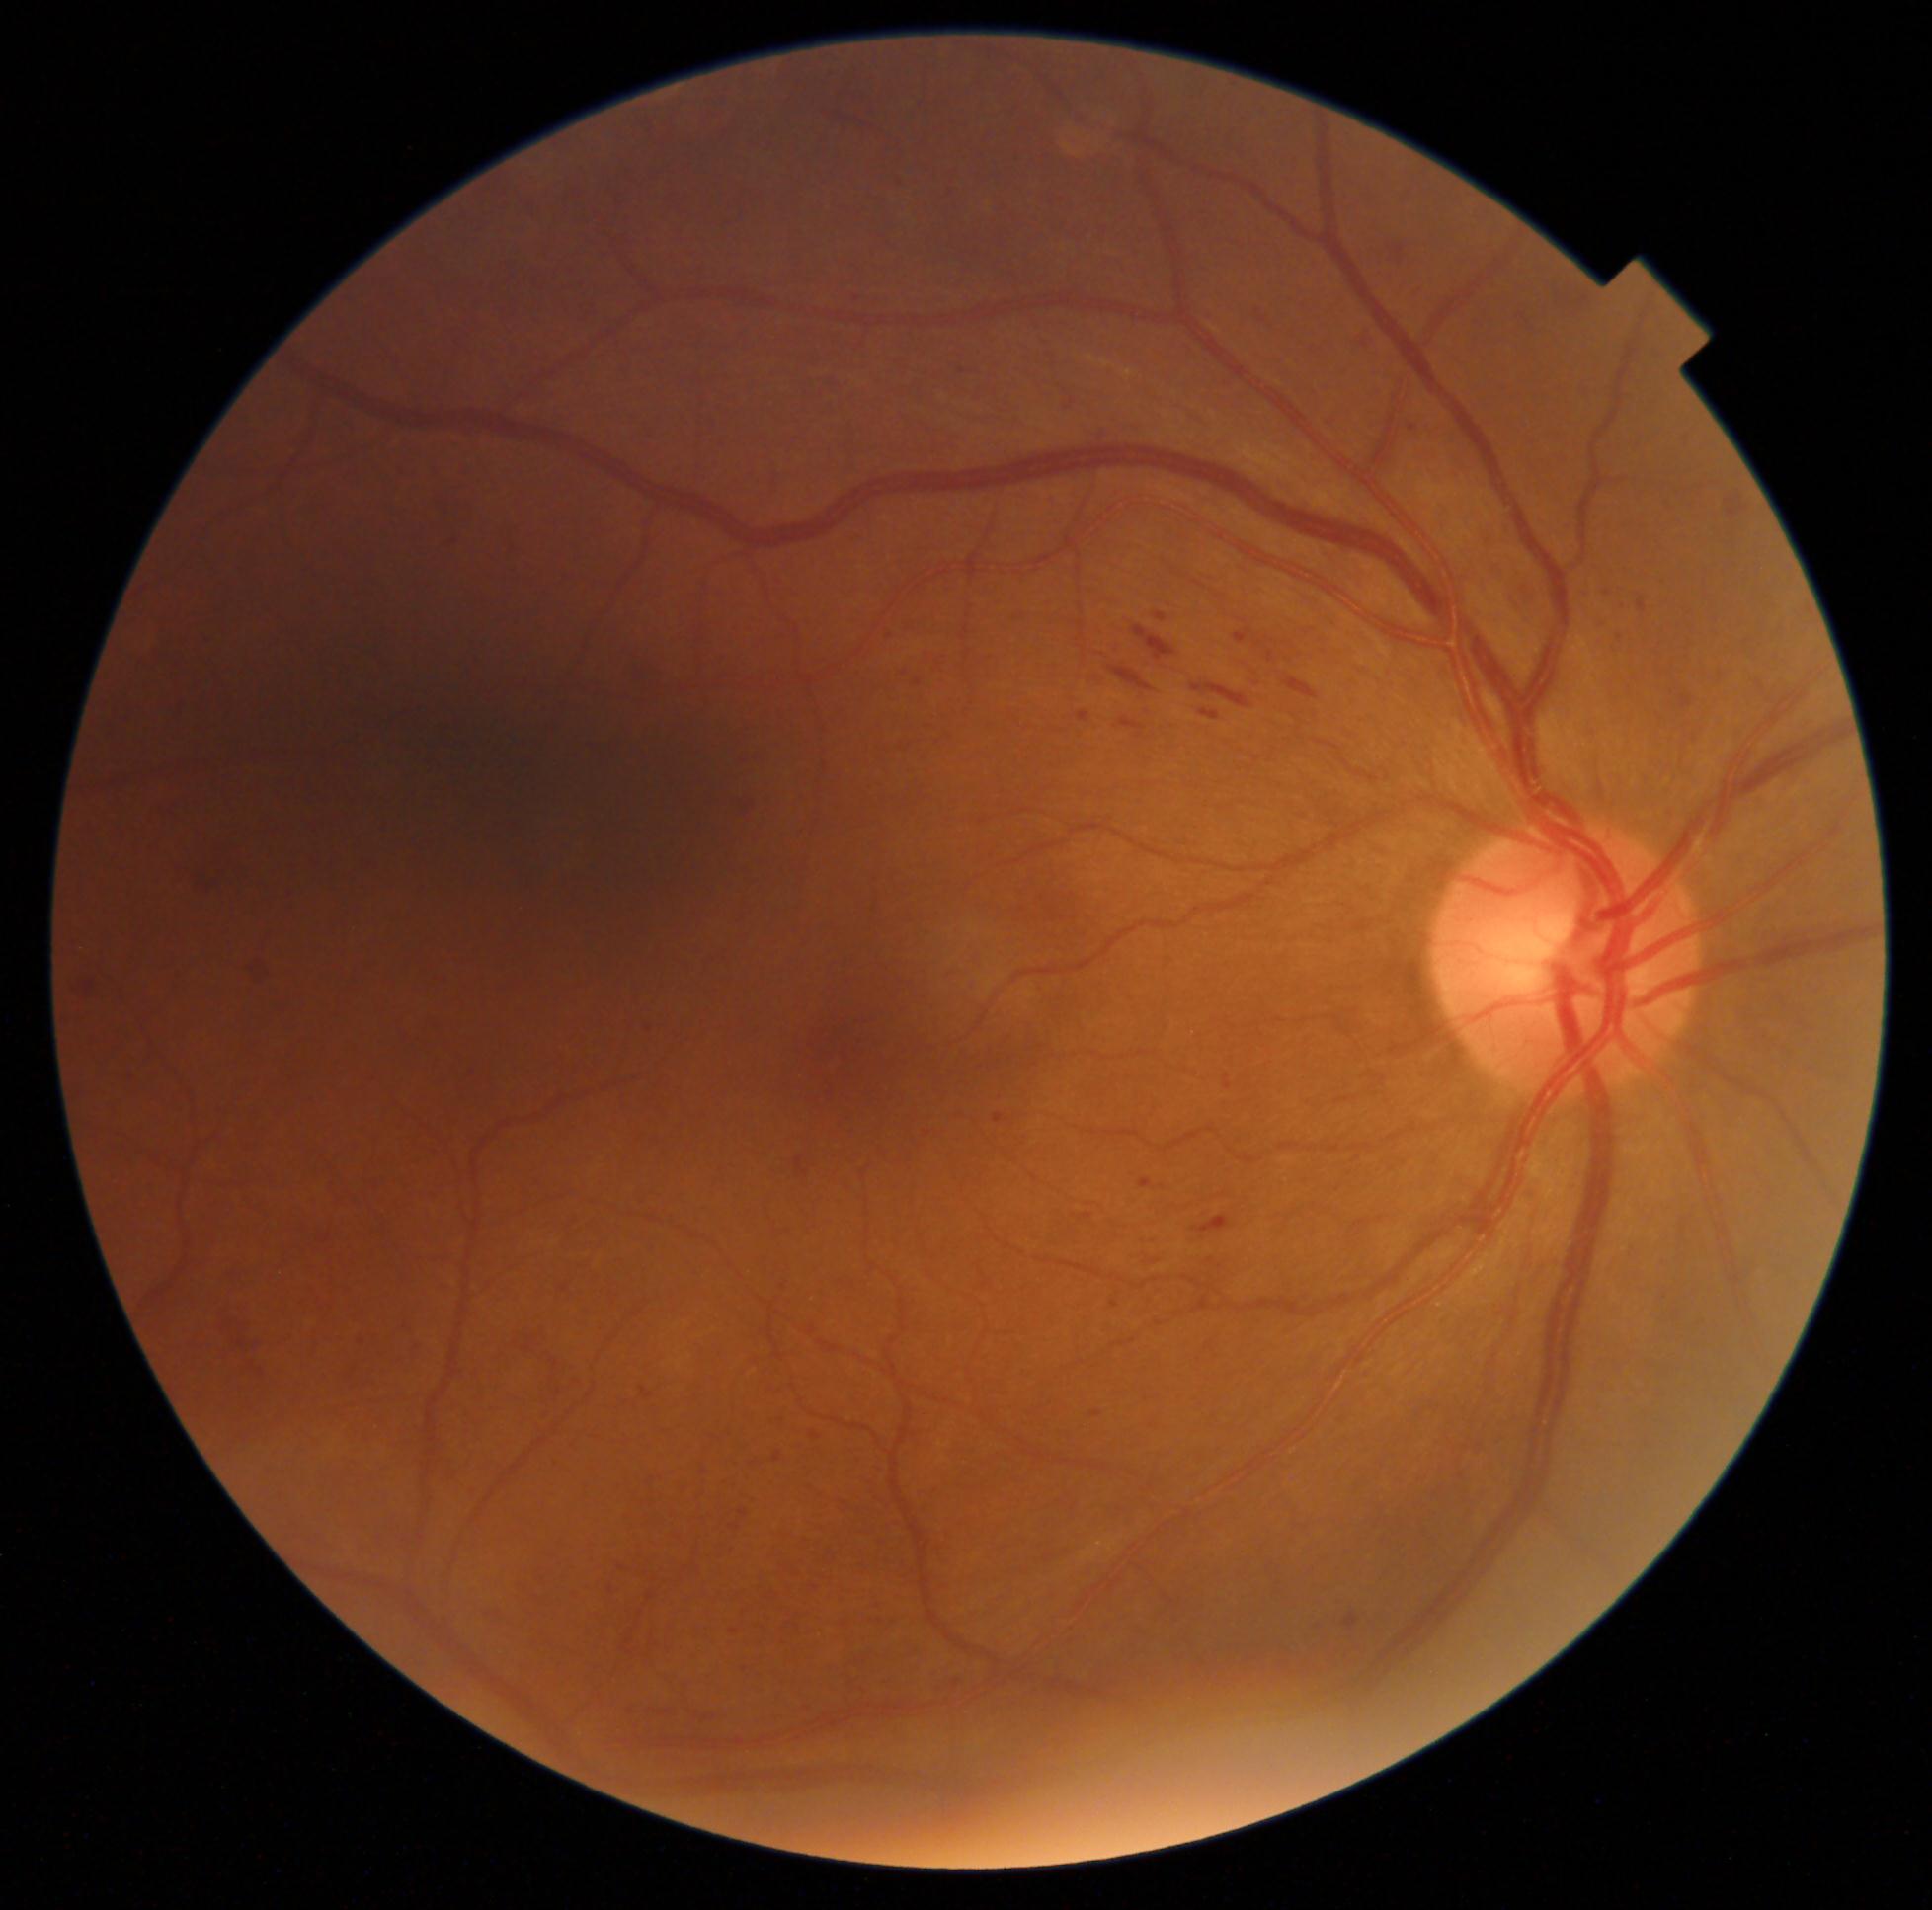
Annotations:
- diabetic retinopathy (DR): grade 2 (moderate NPDR)